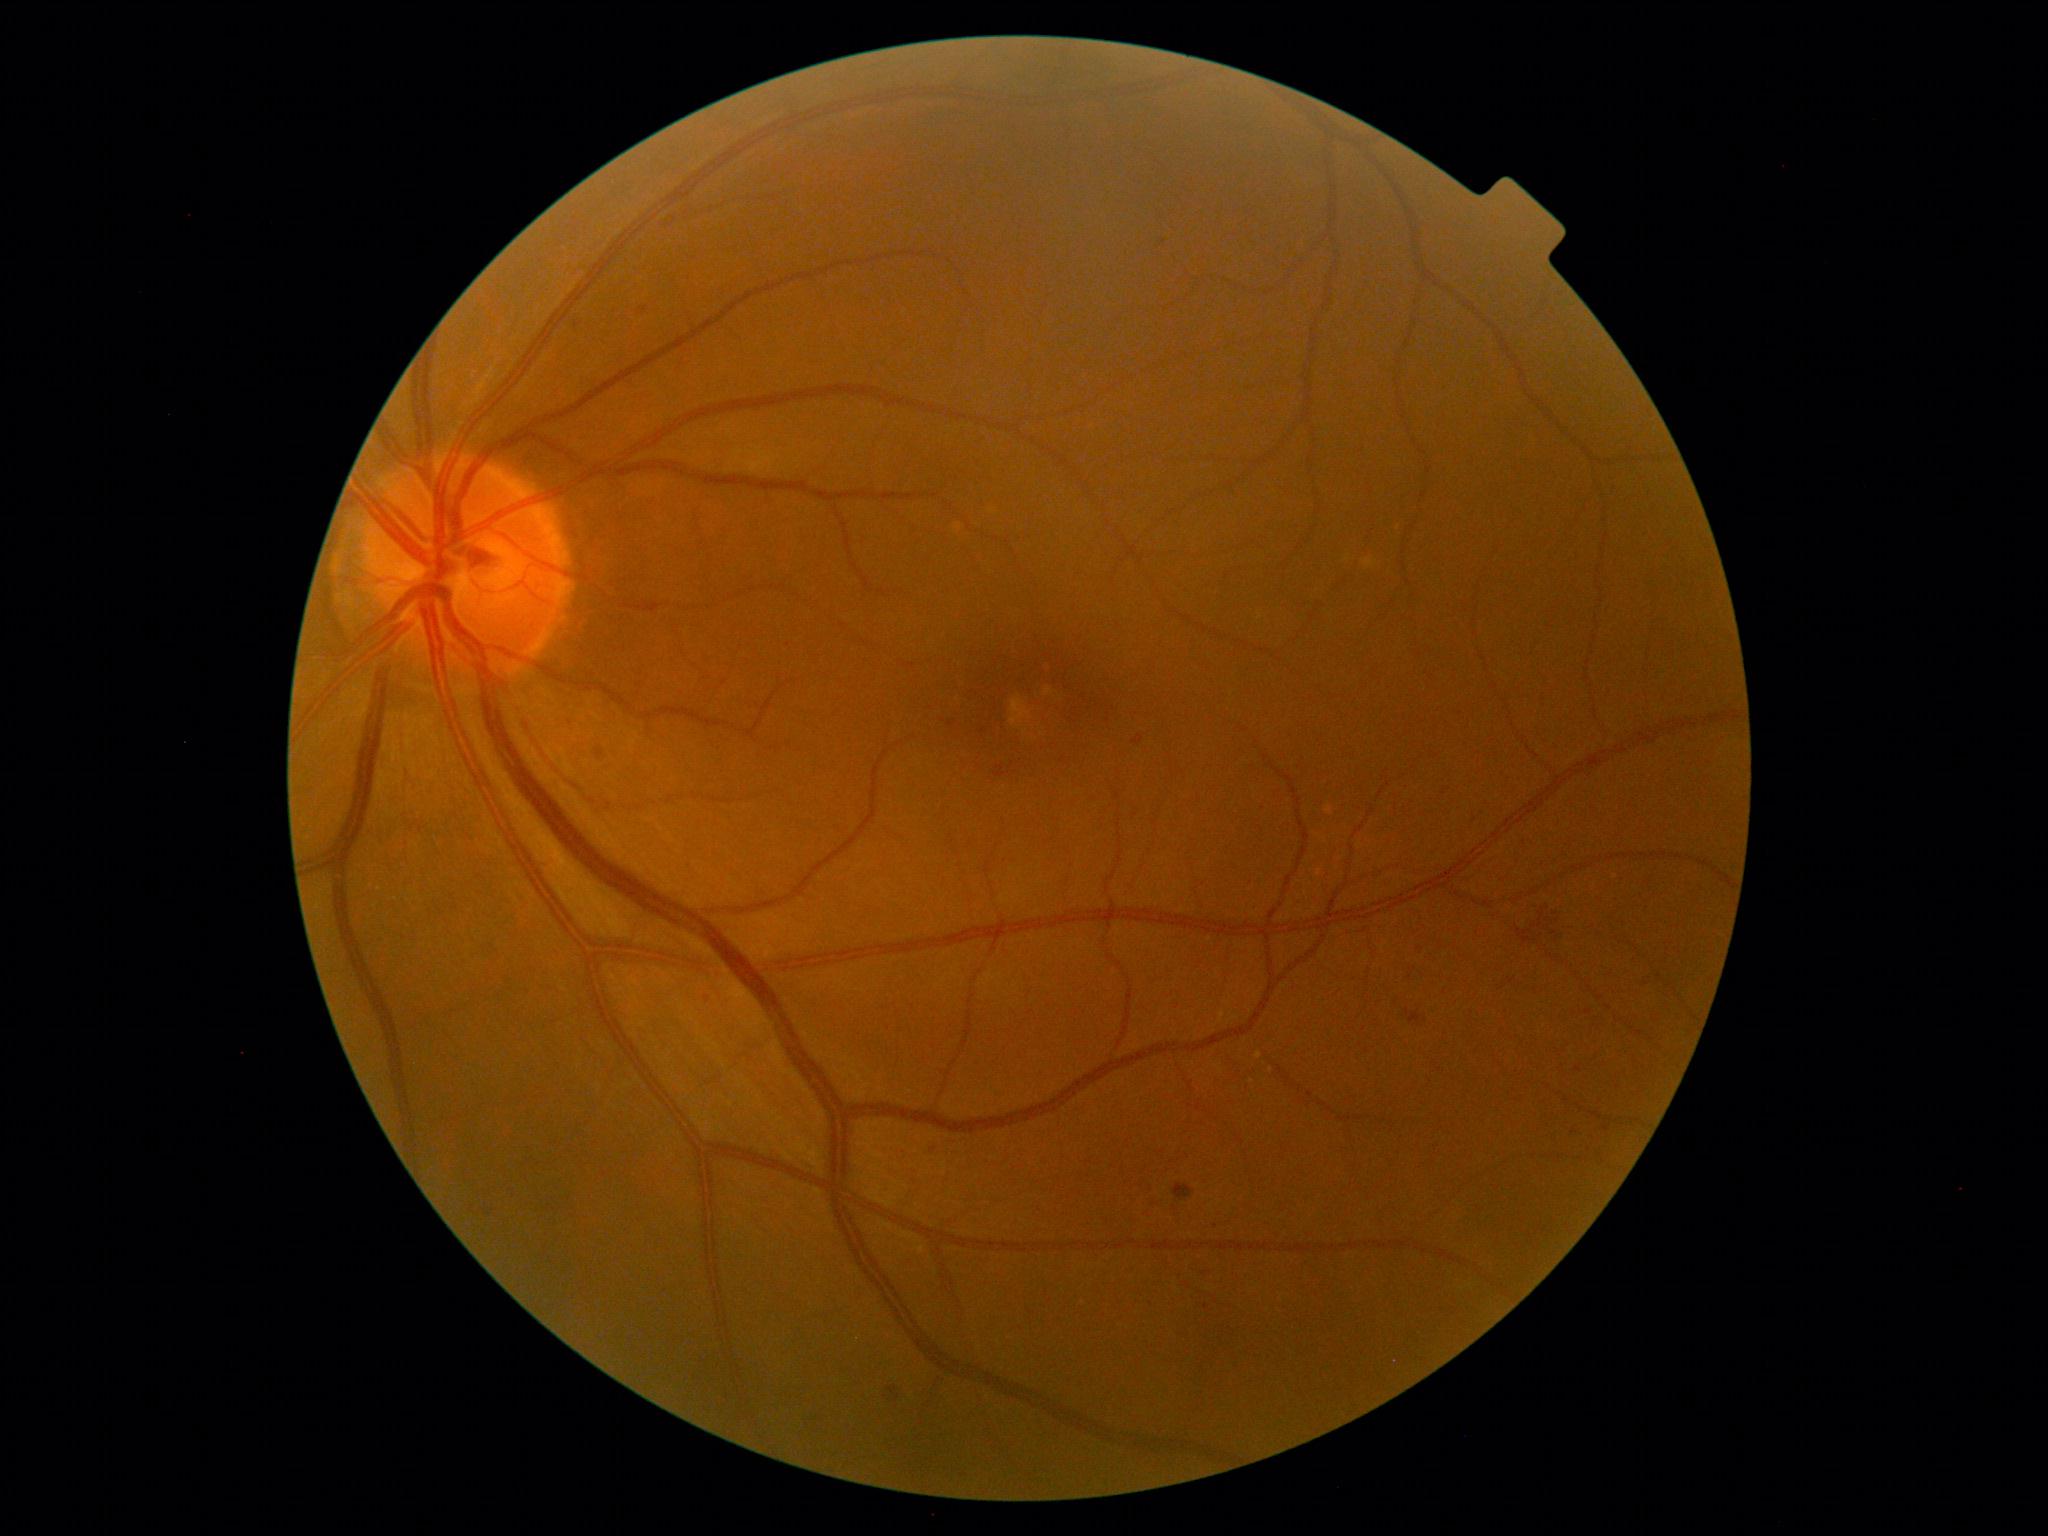
{
  "dr_category": "non-proliferative diabetic retinopathy",
  "dr_grade": "grade 2 (moderate NPDR)"
}